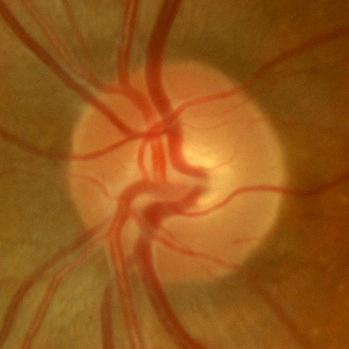
No glaucomatous changes.